DR severity per modified Davis staging.
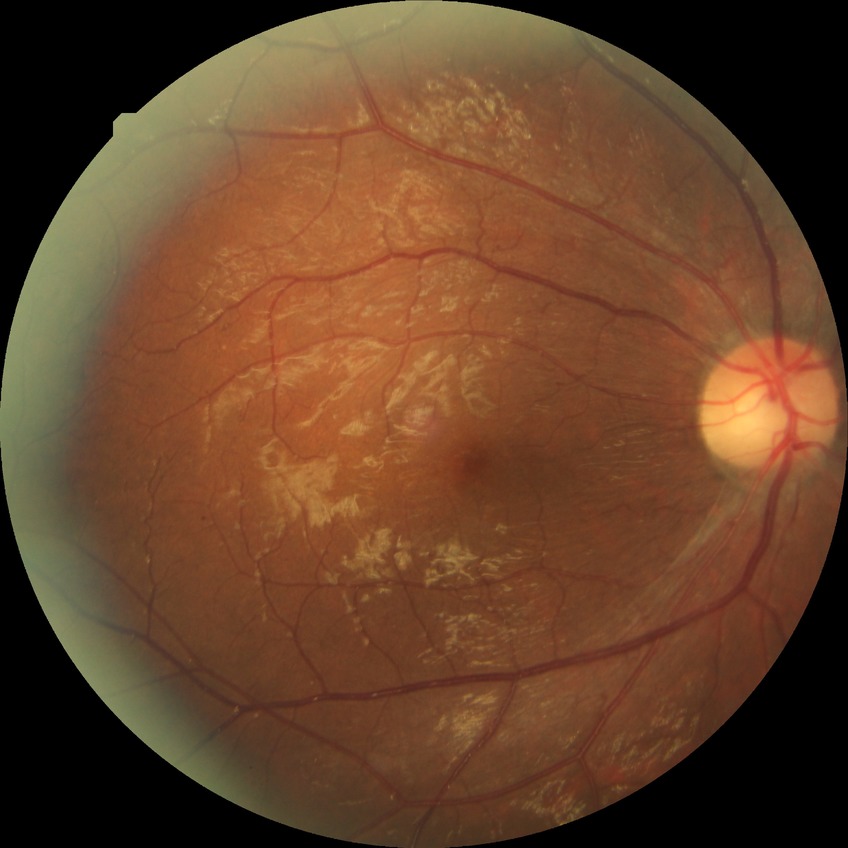

Findings:
– DR grade — PDR